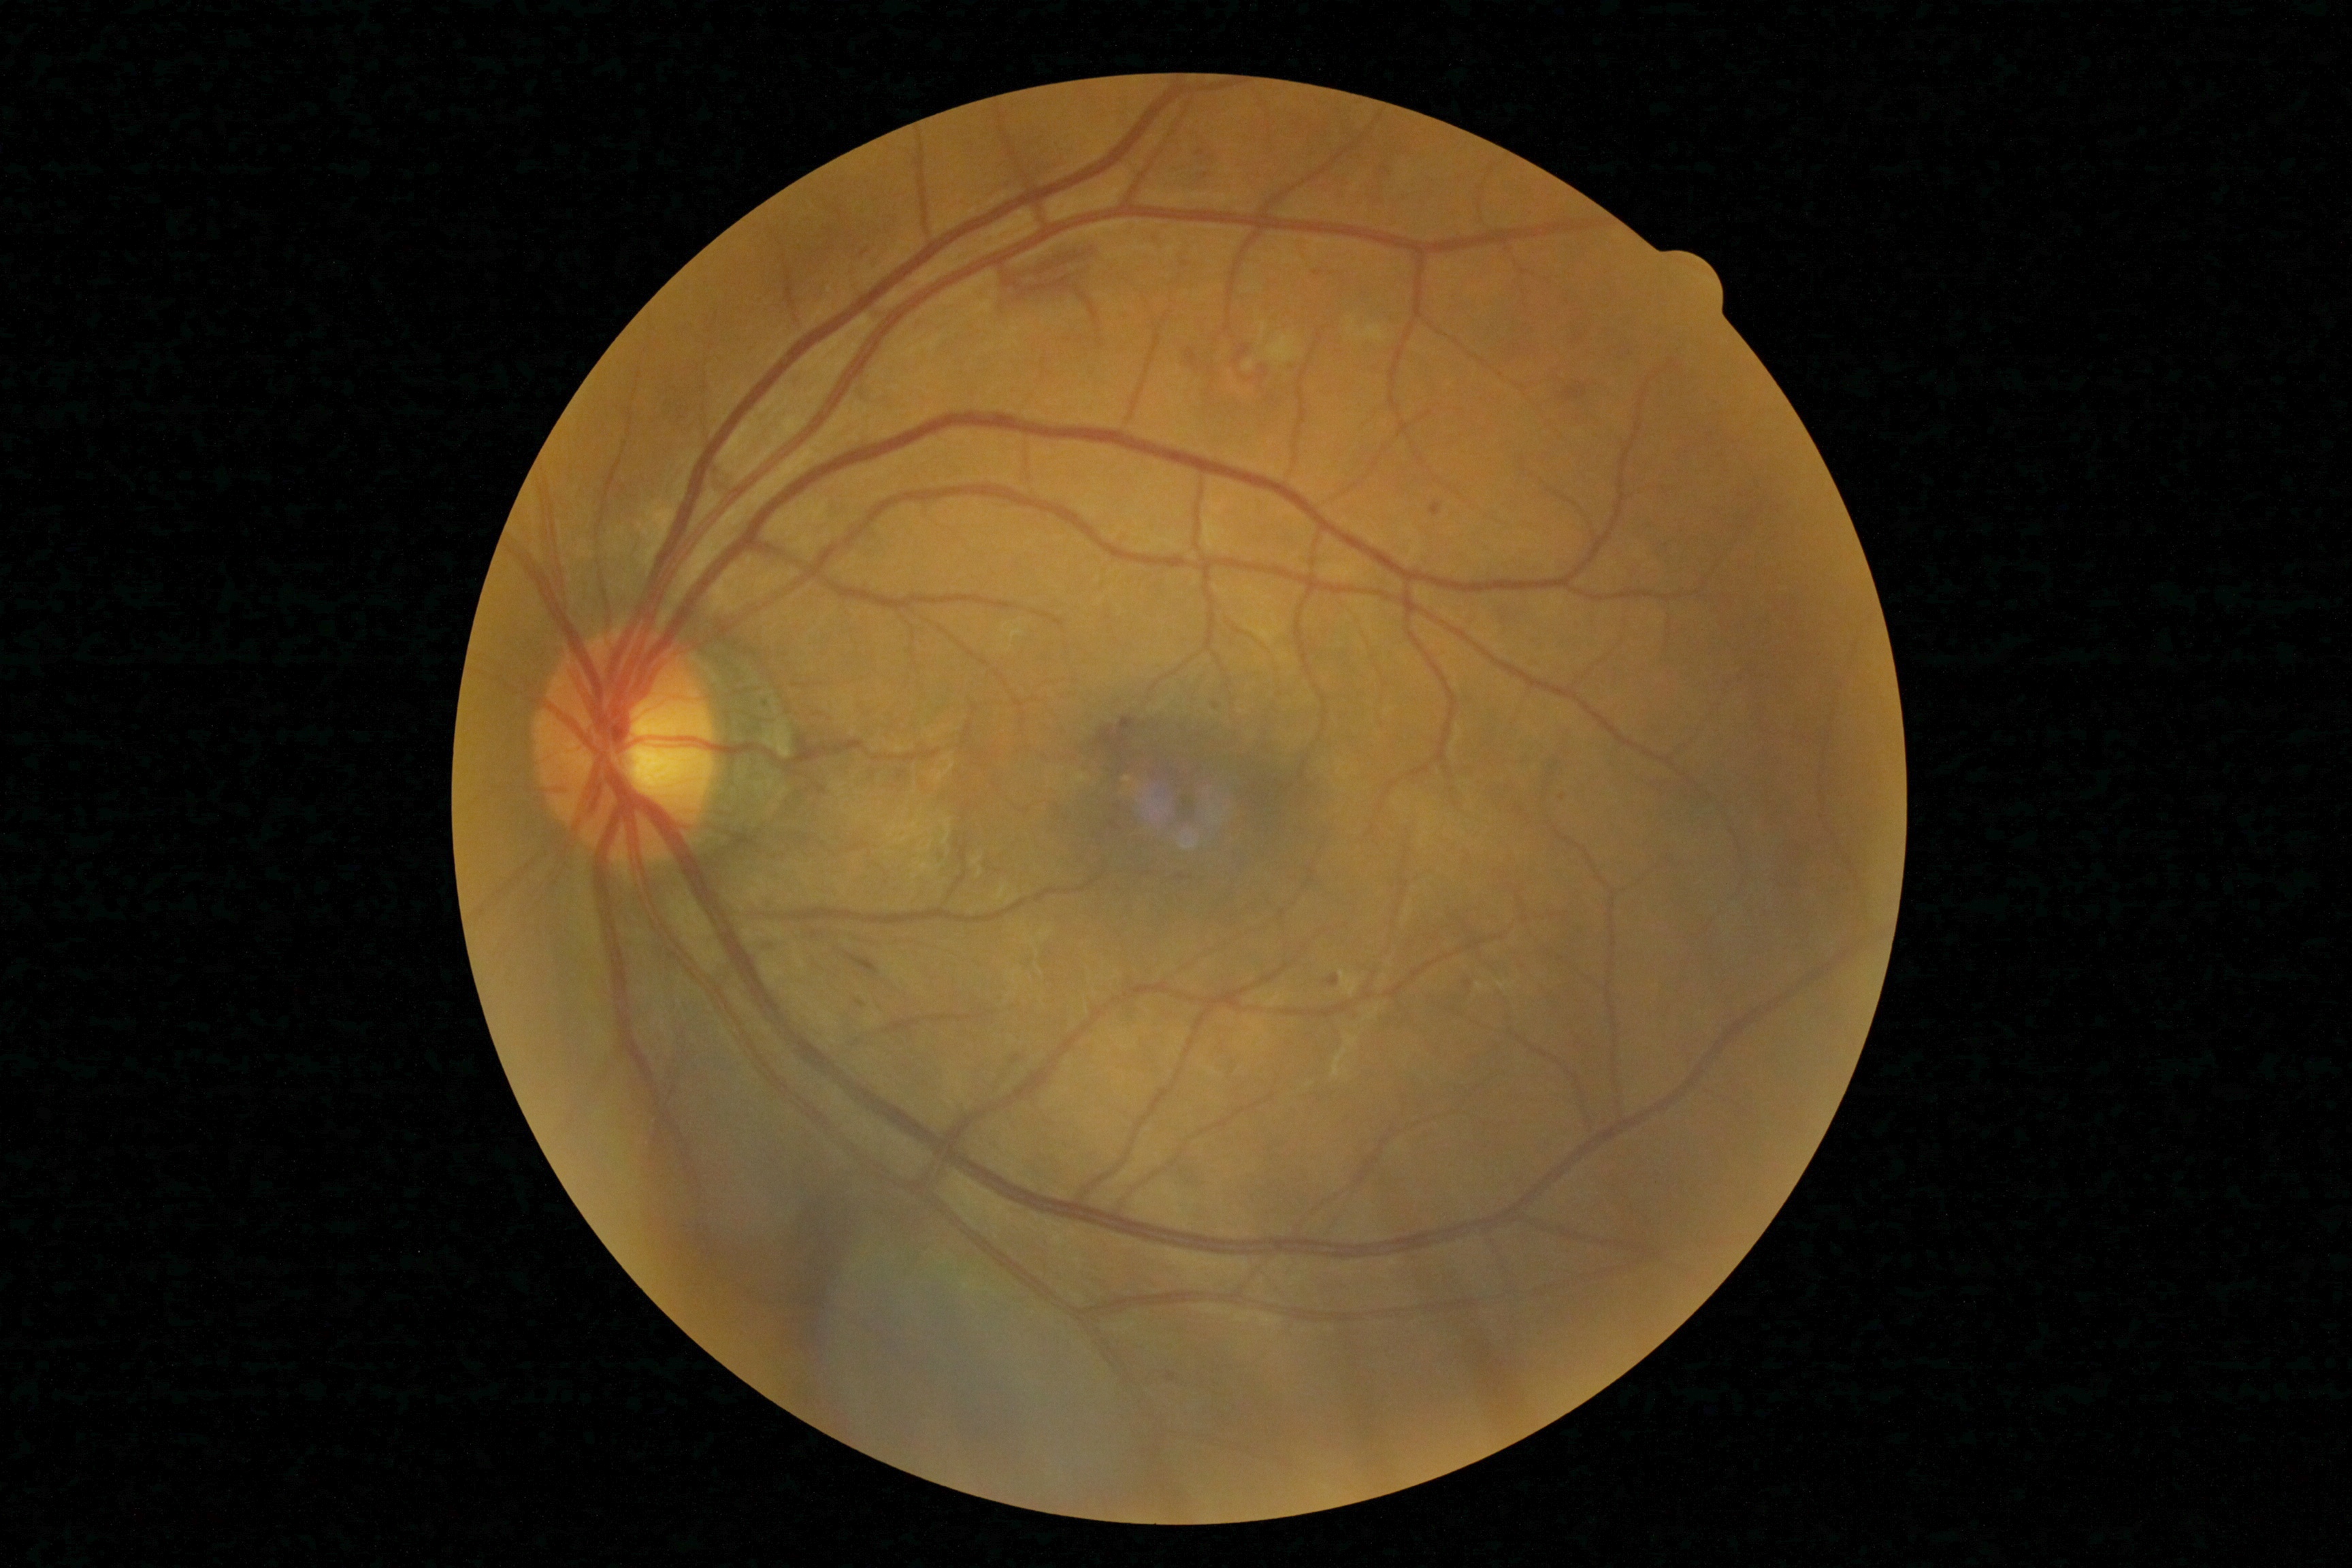

{"dr_category": "non-proliferative diabetic retinopathy", "dr_grade": "grade 2 (moderate NPDR) — more than just microaneurysms but less than severe NPDR"}